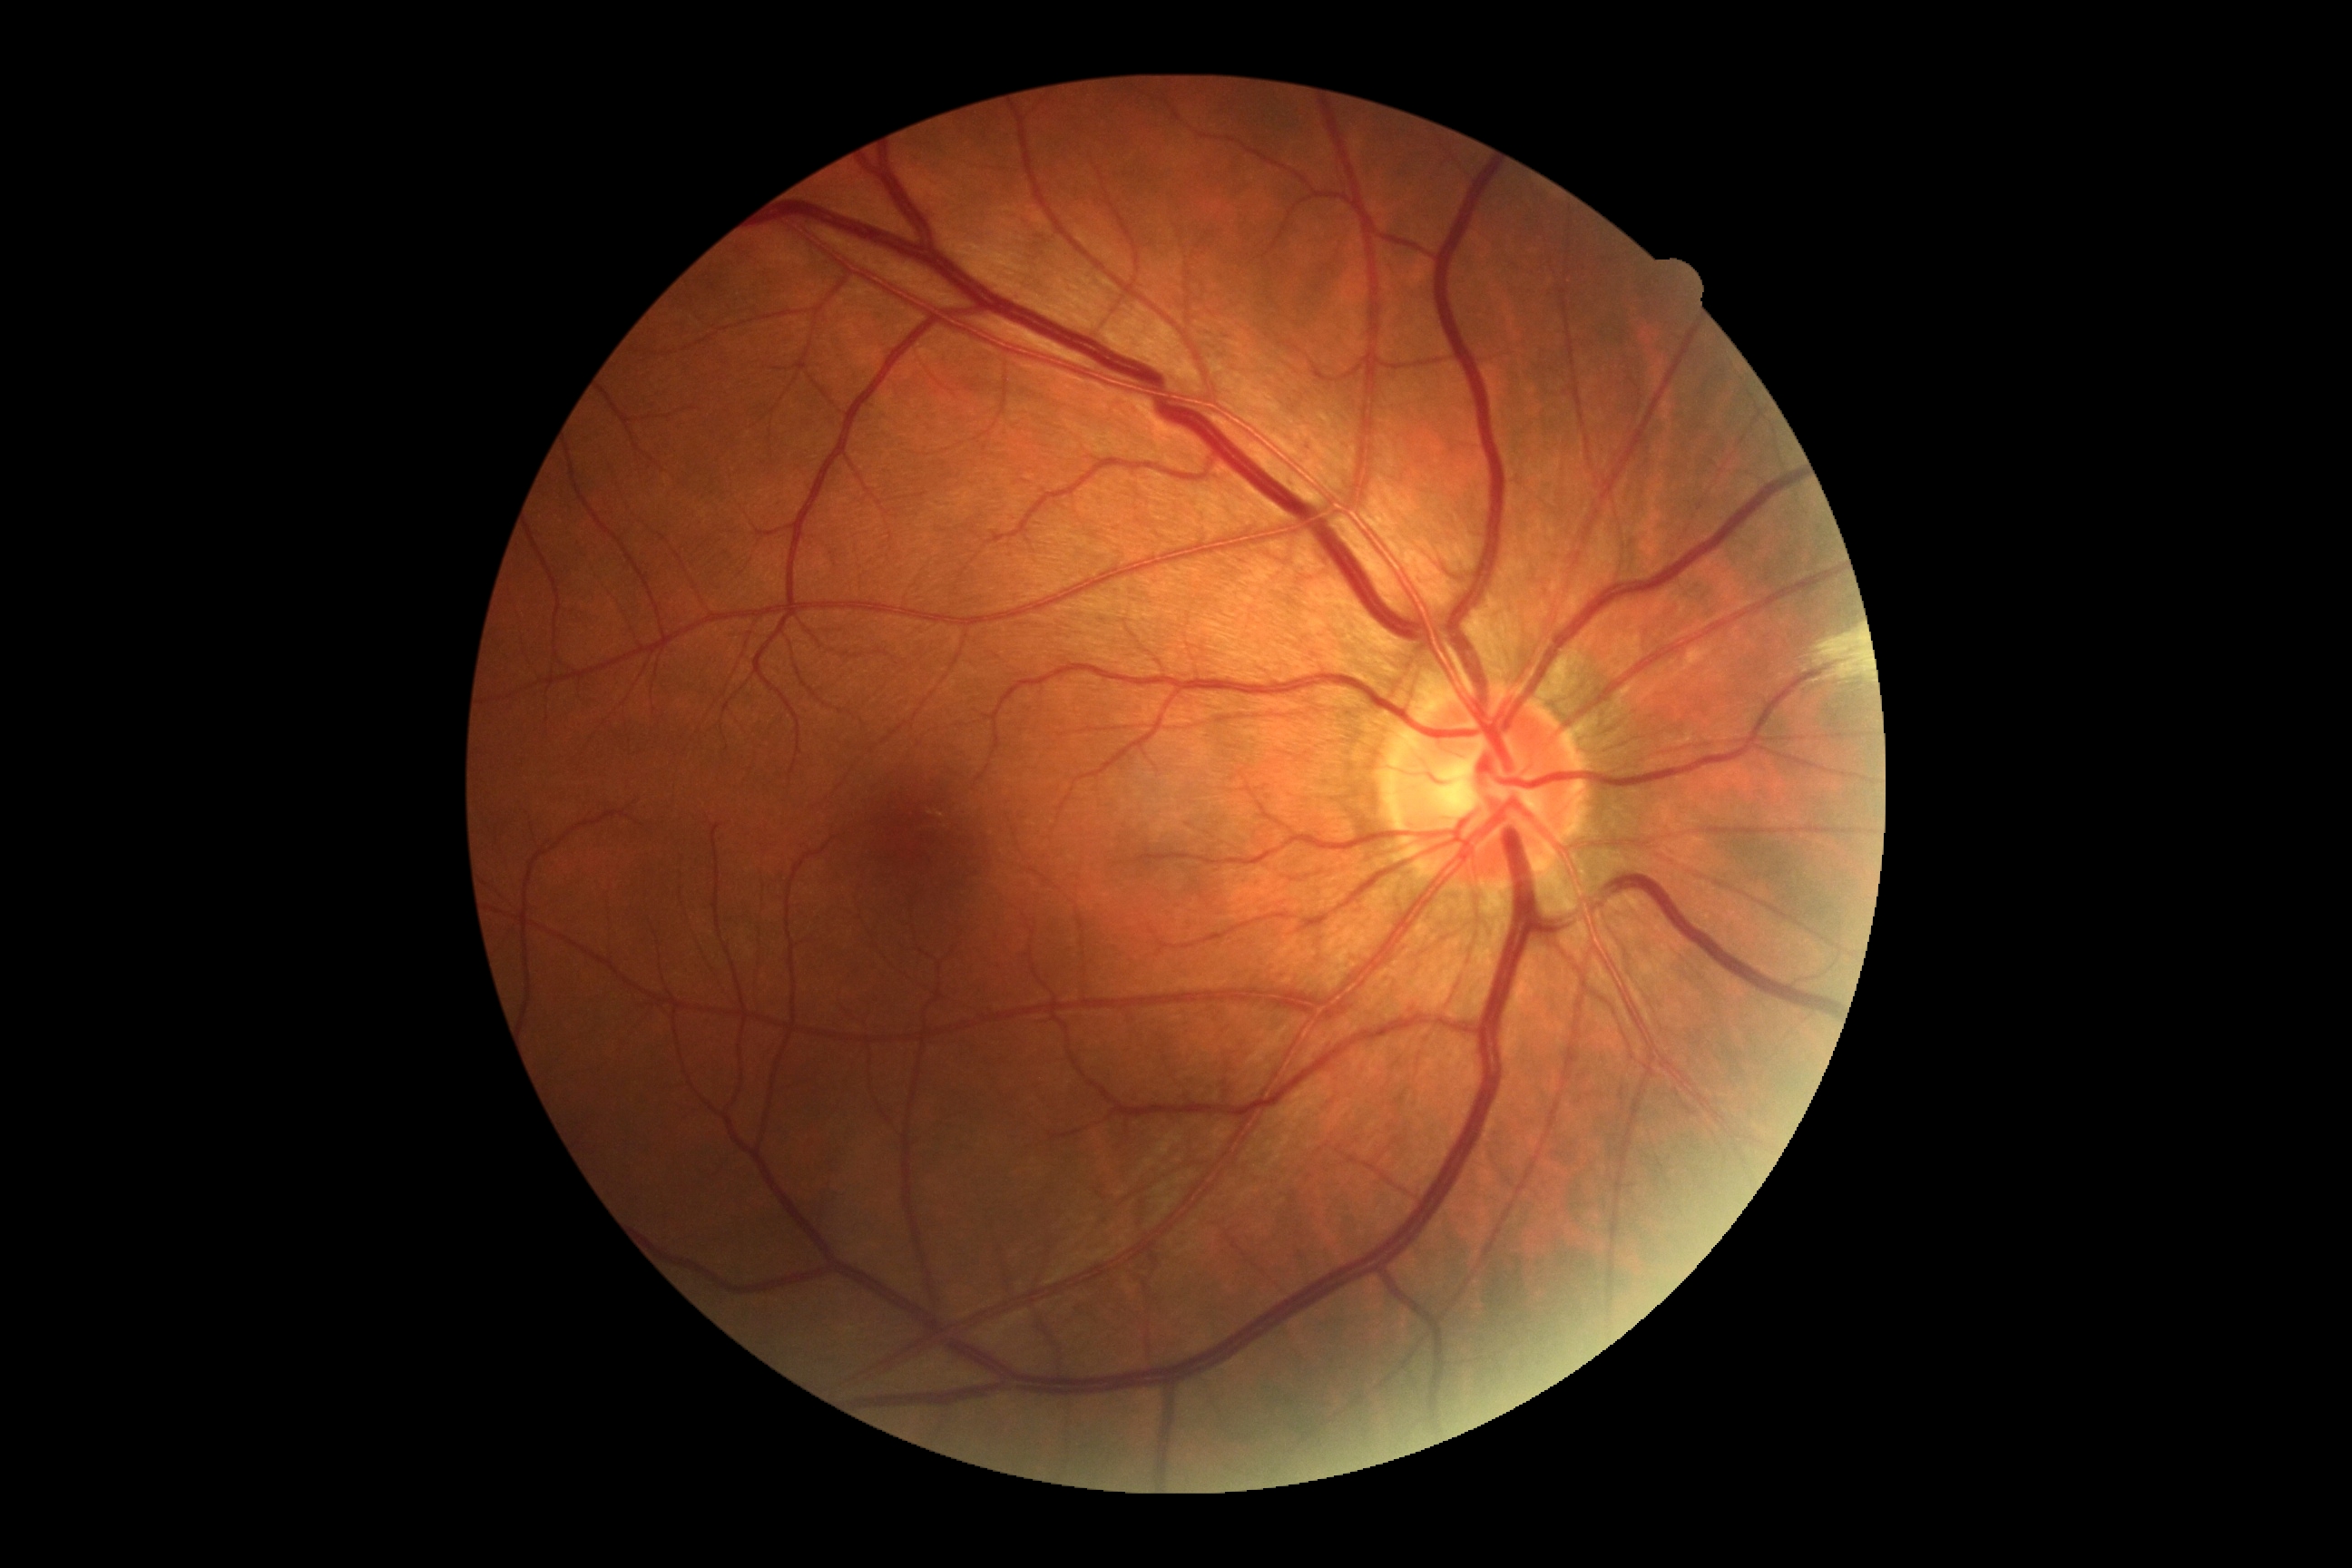
DR is no apparent retinopathy (grade 0).
No apparent diabetic retinopathy.